Color fundus image; camera: NIDEK AFC-230.
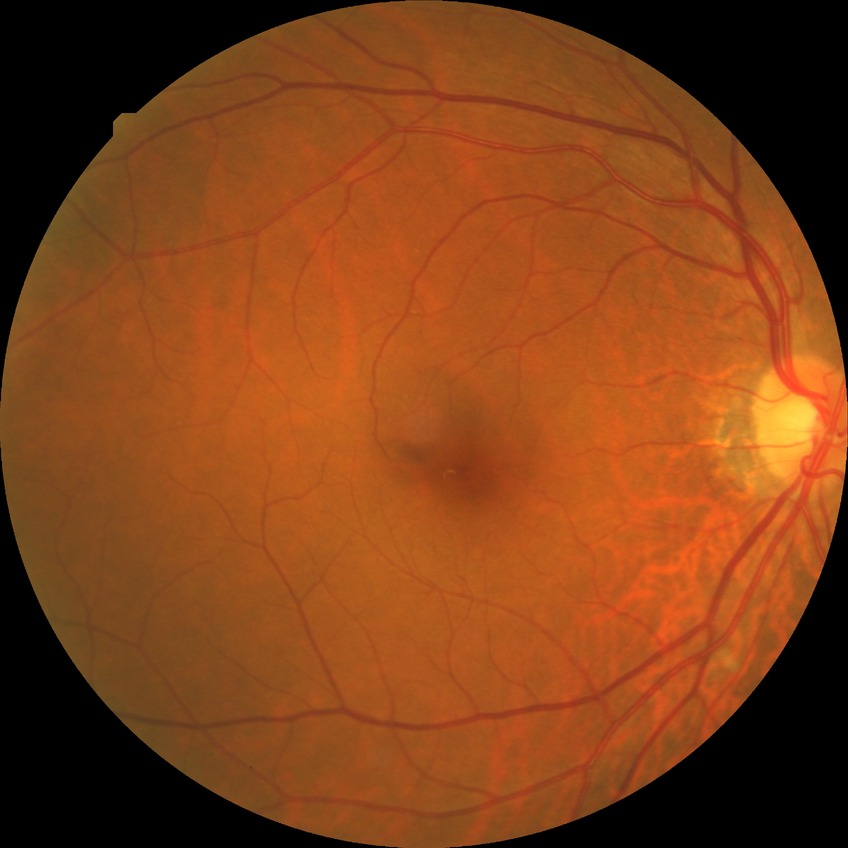
Diabetic retinopathy (DR): simple diabetic retinopathy (SDR).